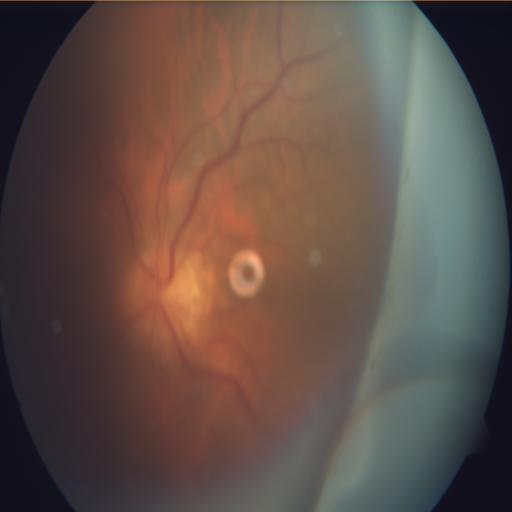
Findings consistent with optic disc edema.